45° FOV · retinal fundus photograph · 2352x1568 — 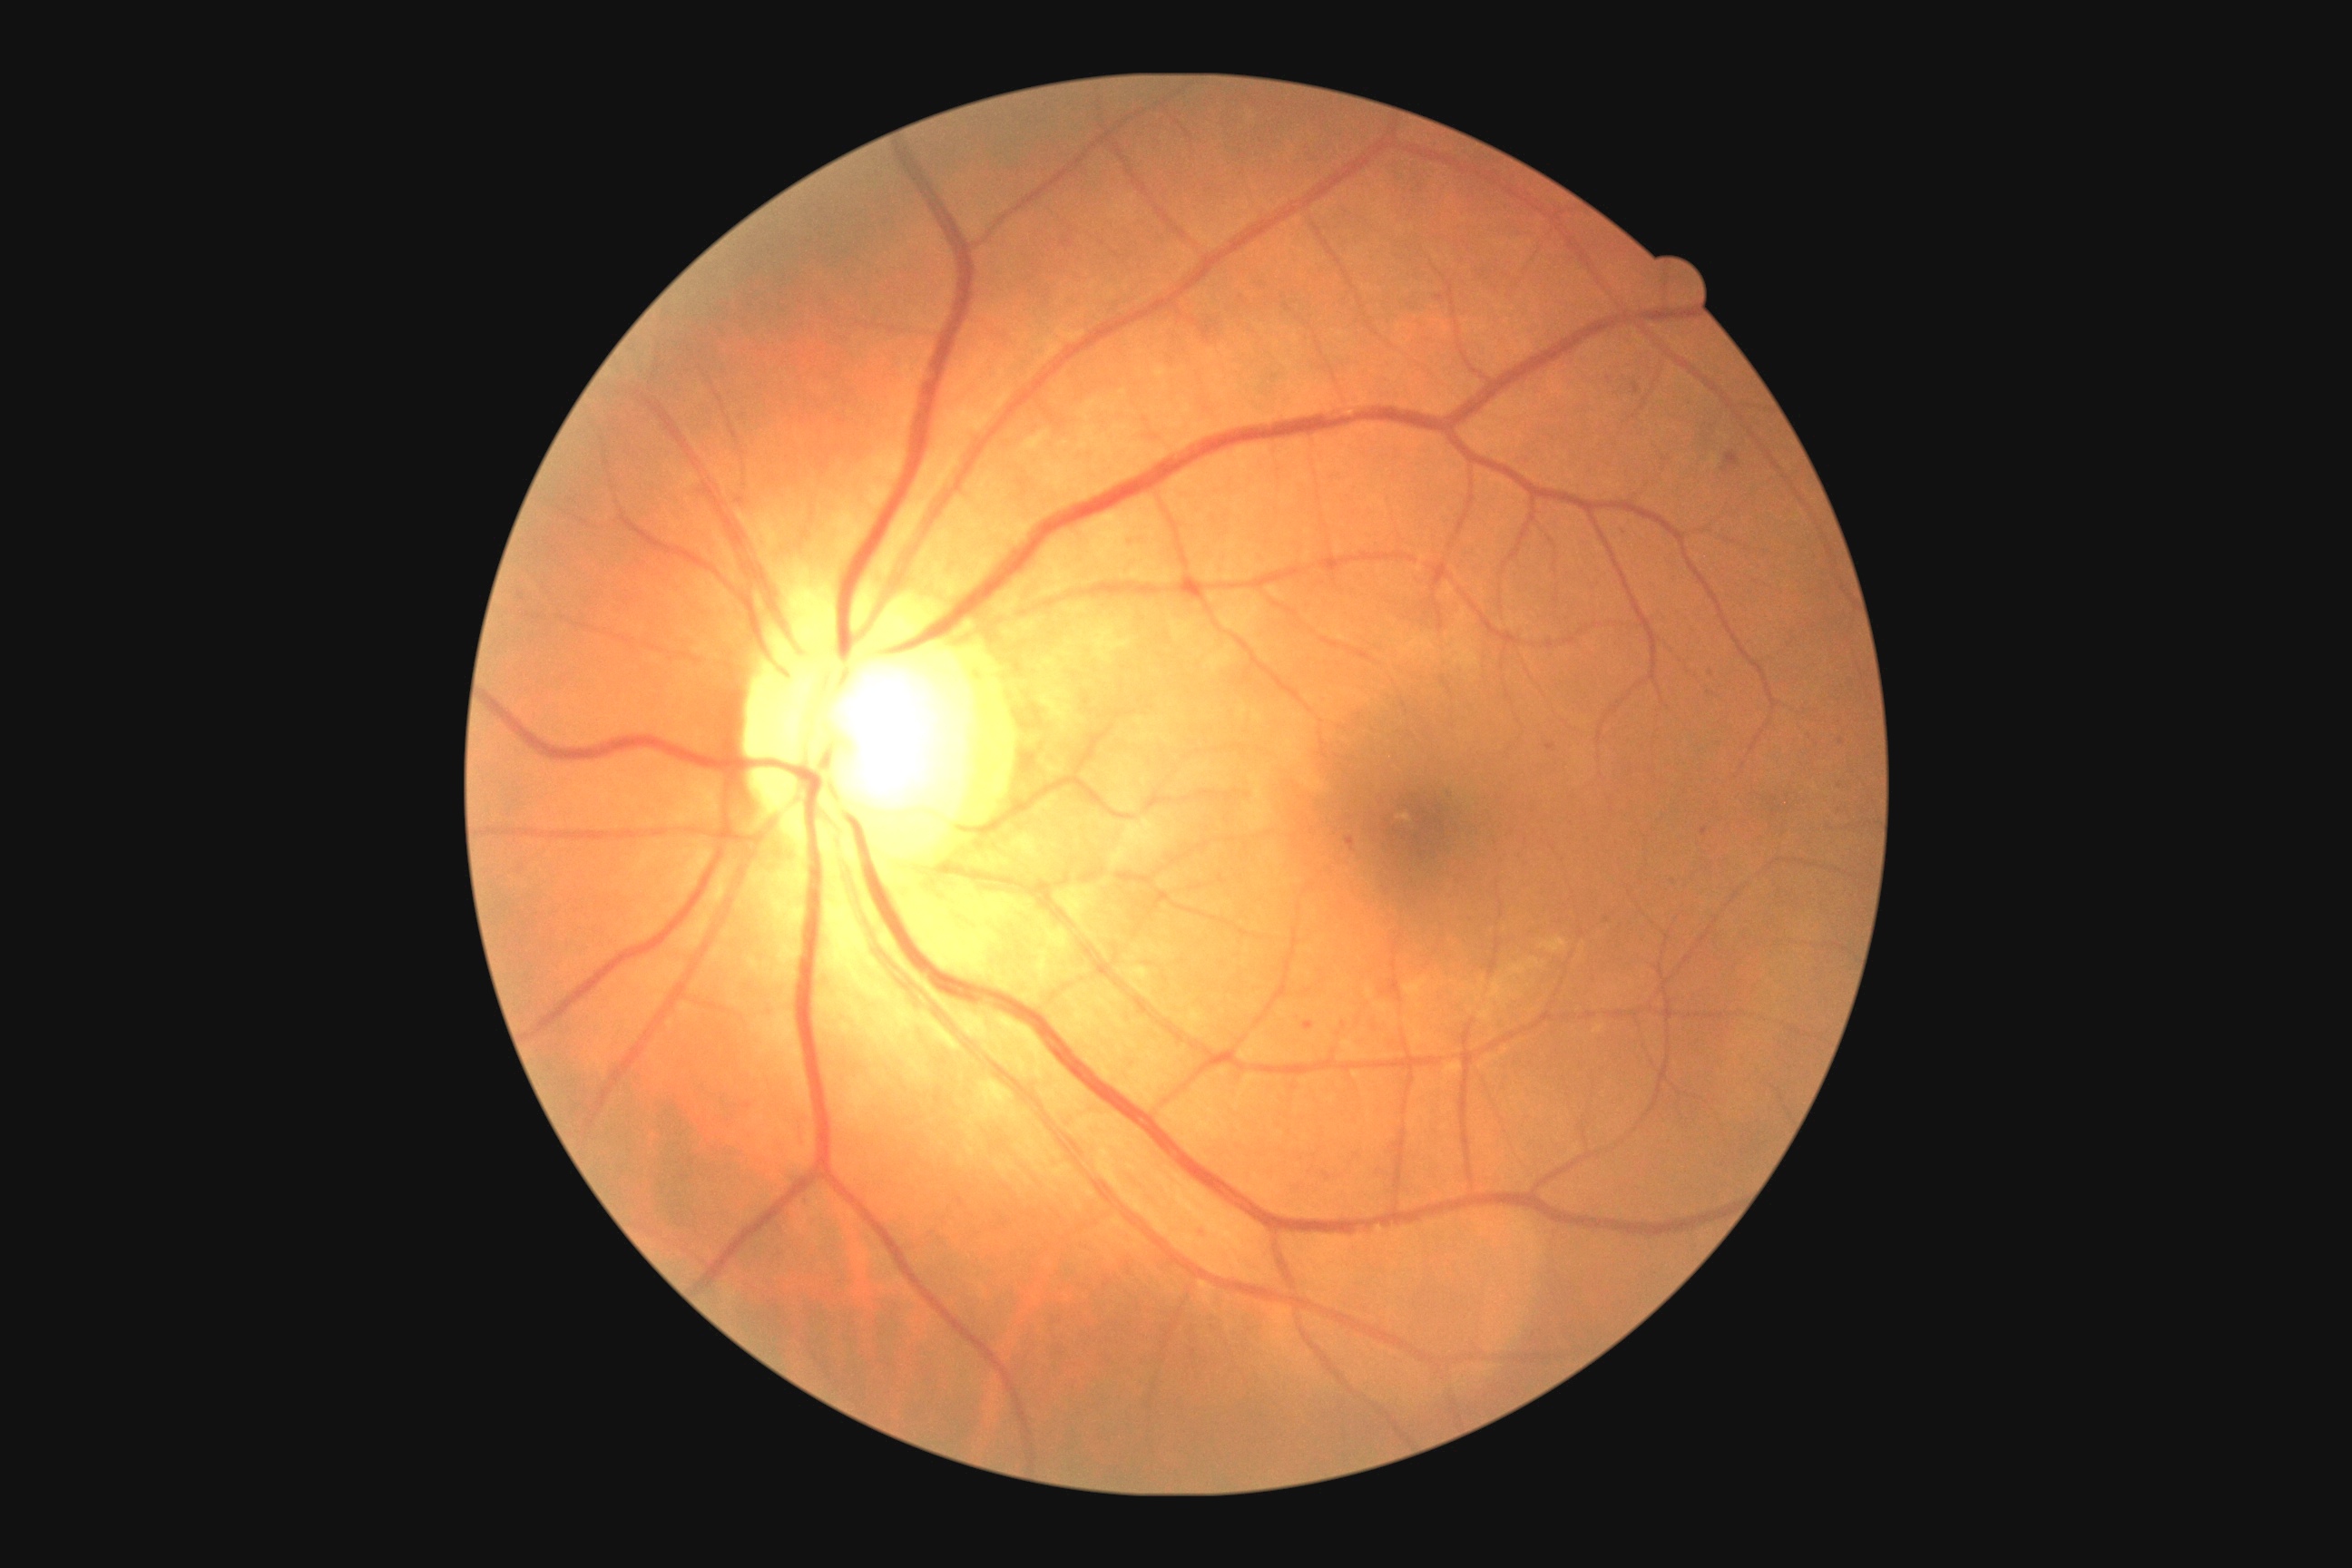

DR severity is grade 1 (mild NPDR)
Representative lesions:
SEs = not present
EXs = not present
HEs = not present
MAs (partial) = (x1=1346, y1=838, x2=1355, y2=850), (x1=1701, y1=828, x2=1709, y2=836), (x1=1632, y1=382, x2=1642, y2=395), (x1=1126, y1=538, x2=1142, y2=551), (x1=1547, y1=743, x2=1556, y2=750), (x1=1304, y1=1021, x2=1315, y2=1032), (x1=1199, y1=1230, x2=1213, y2=1244), (x1=1436, y1=295, x2=1444, y2=302), (x1=1727, y1=453, x2=1738, y2=467), (x1=1620, y1=527, x2=1631, y2=540)
Additional small MAs near <point>1609, 380</point>, <point>1712, 674</point>